2352x1568px: 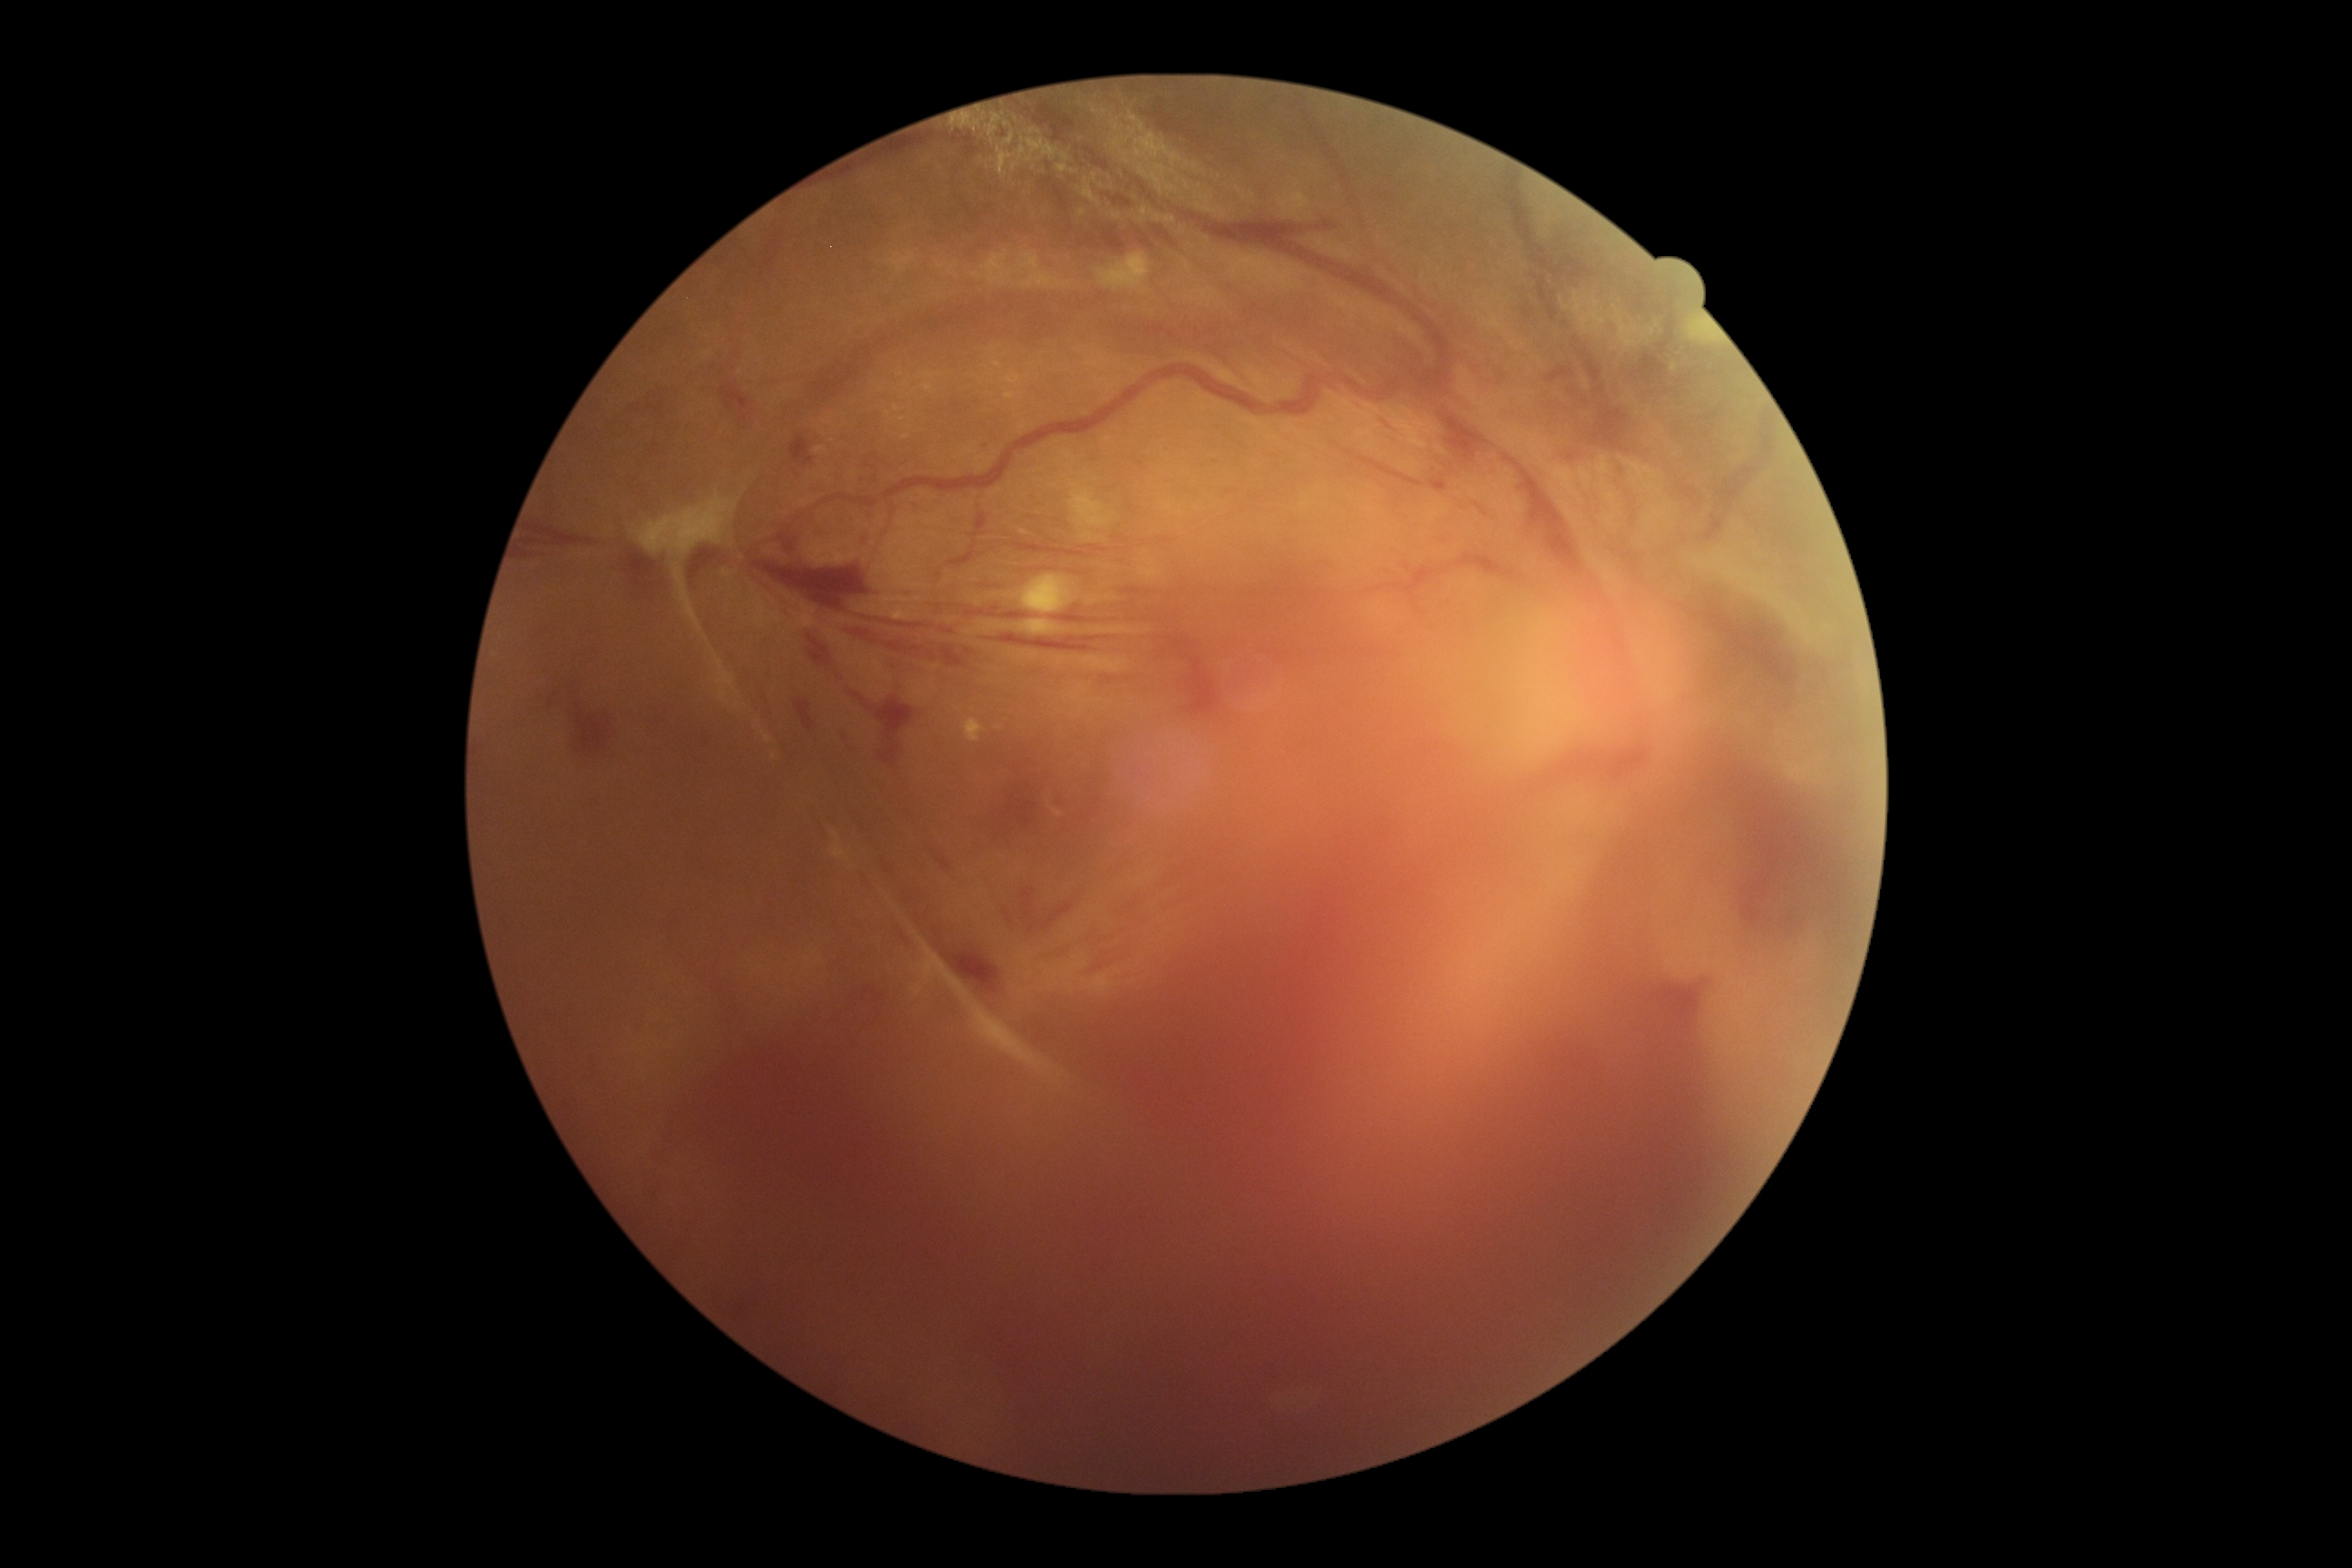 Findings:
– DR grade — proliferative diabetic retinopathy (4)